2352 by 1568 pixels; CFP; 45° field of view — 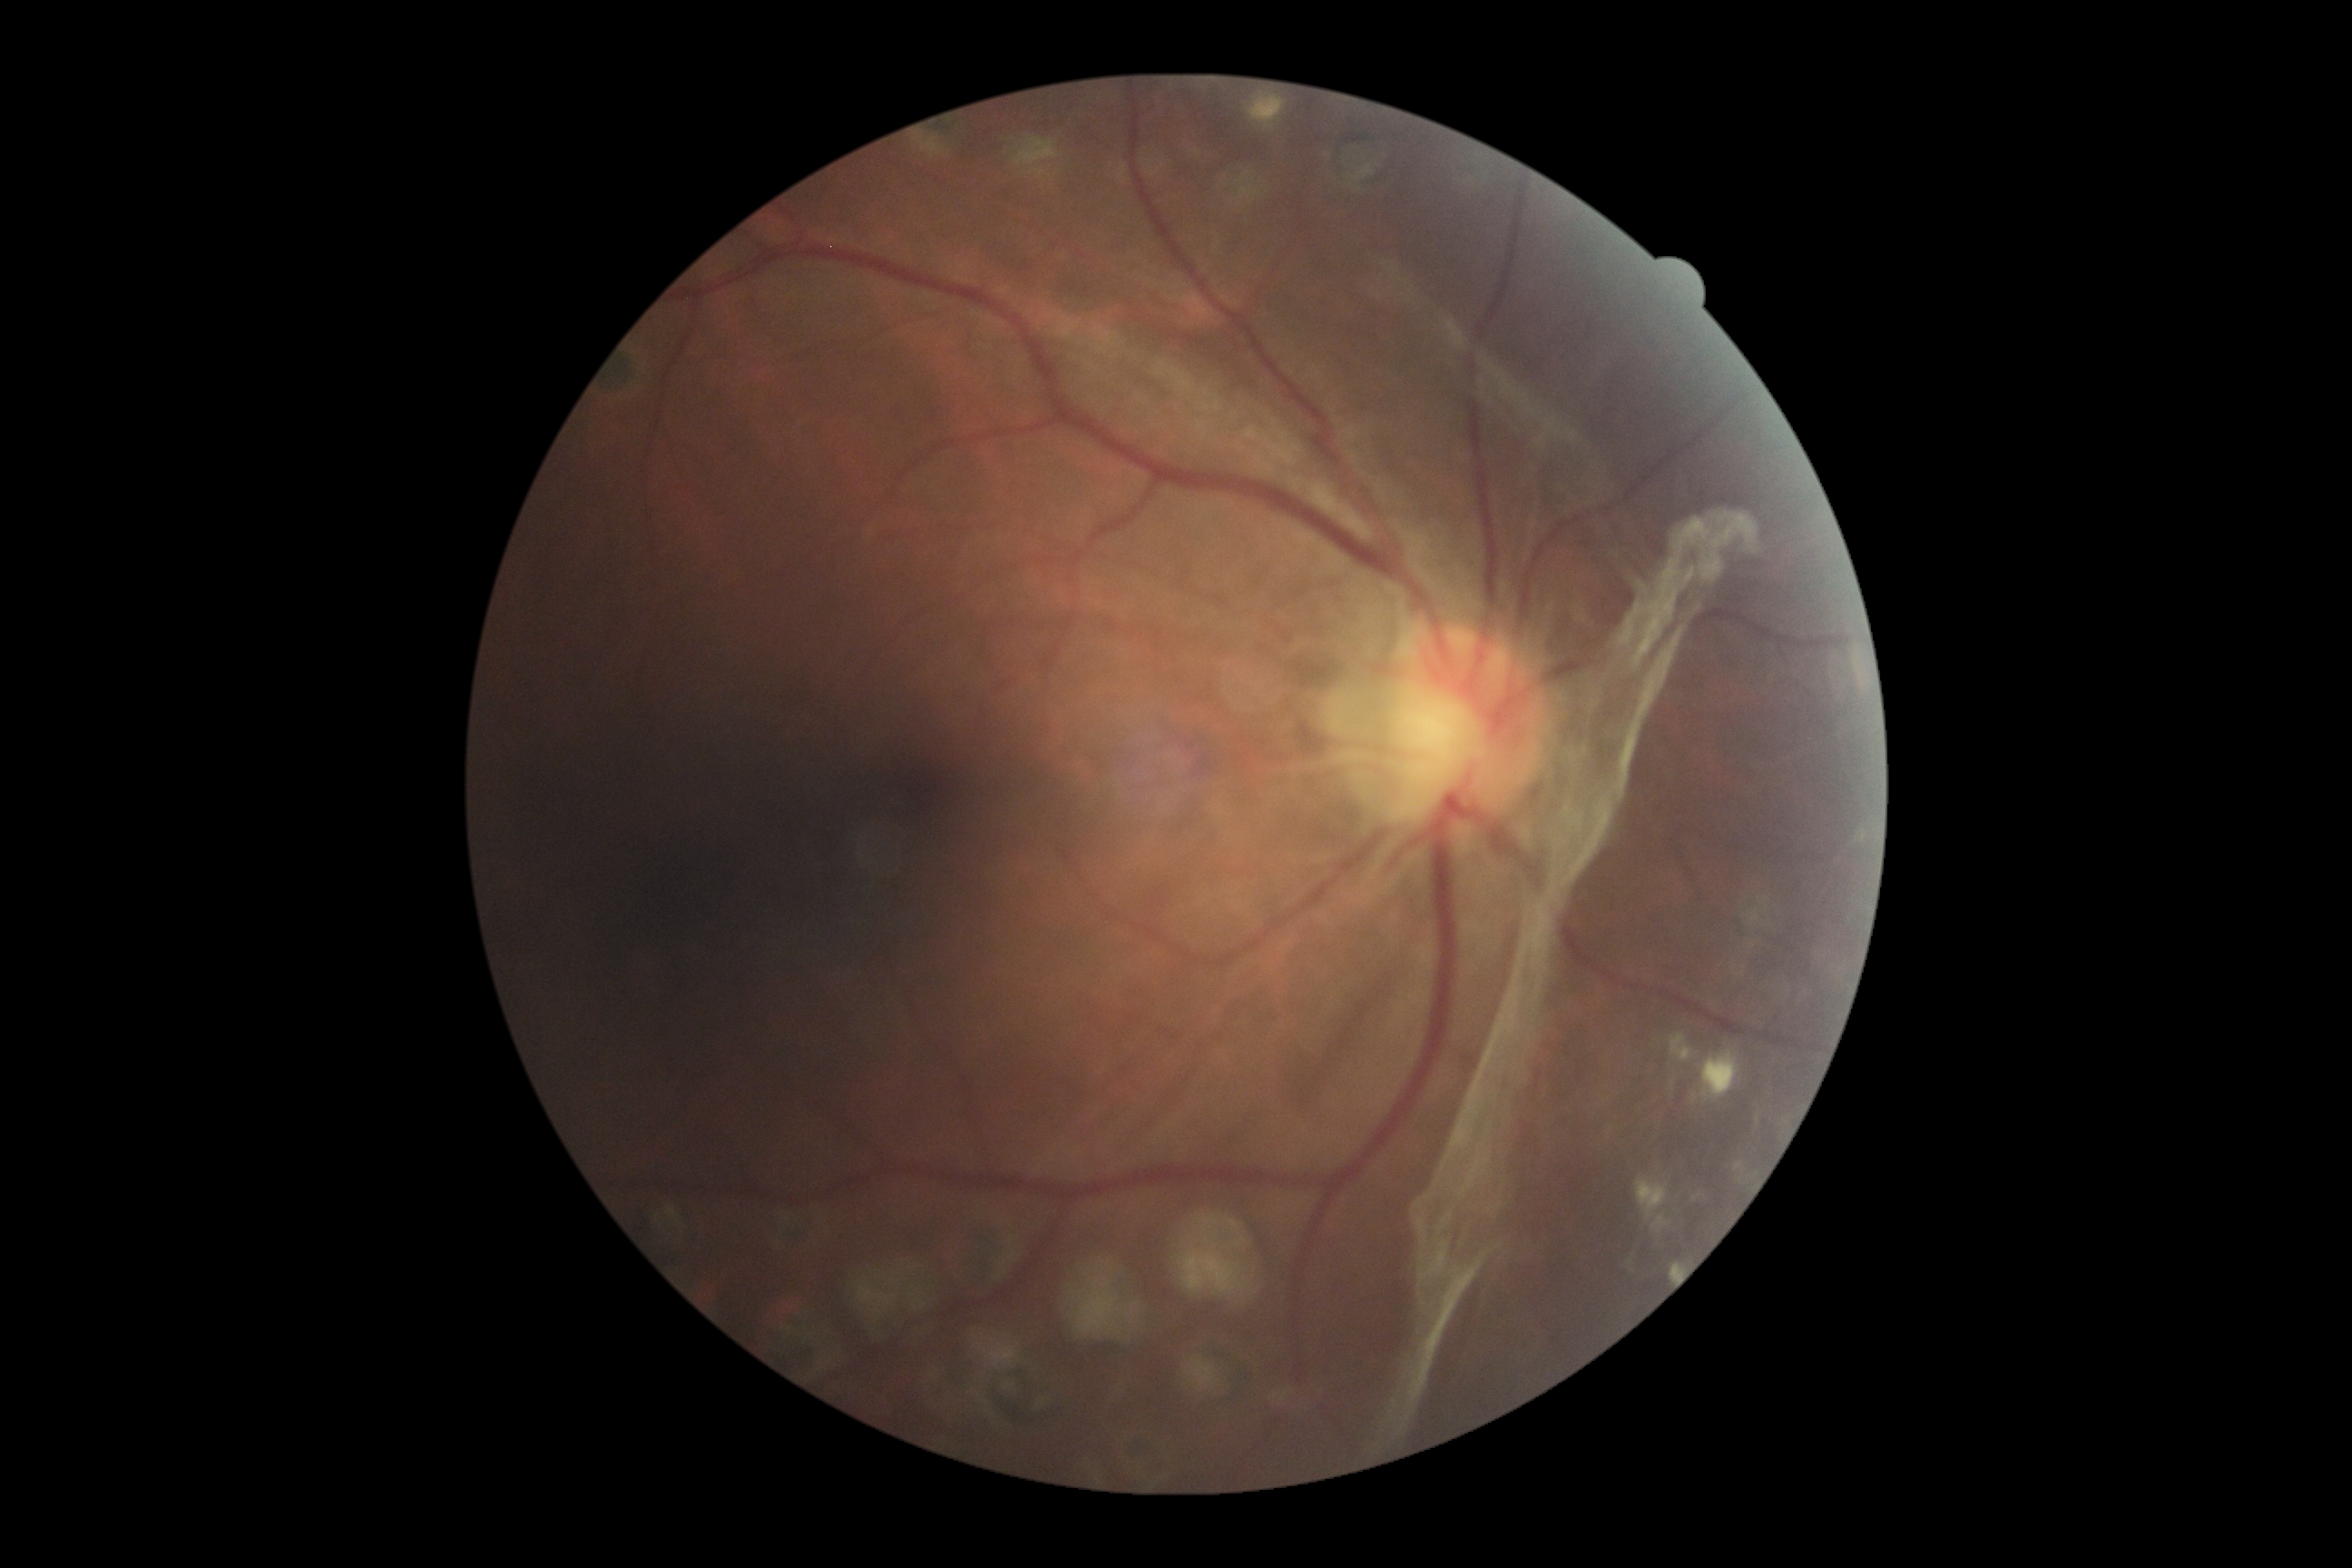

Diabetic retinopathy (DR) is grade 4 (PDR) — neovascularization and/or vitreous/pre-retinal hemorrhage.